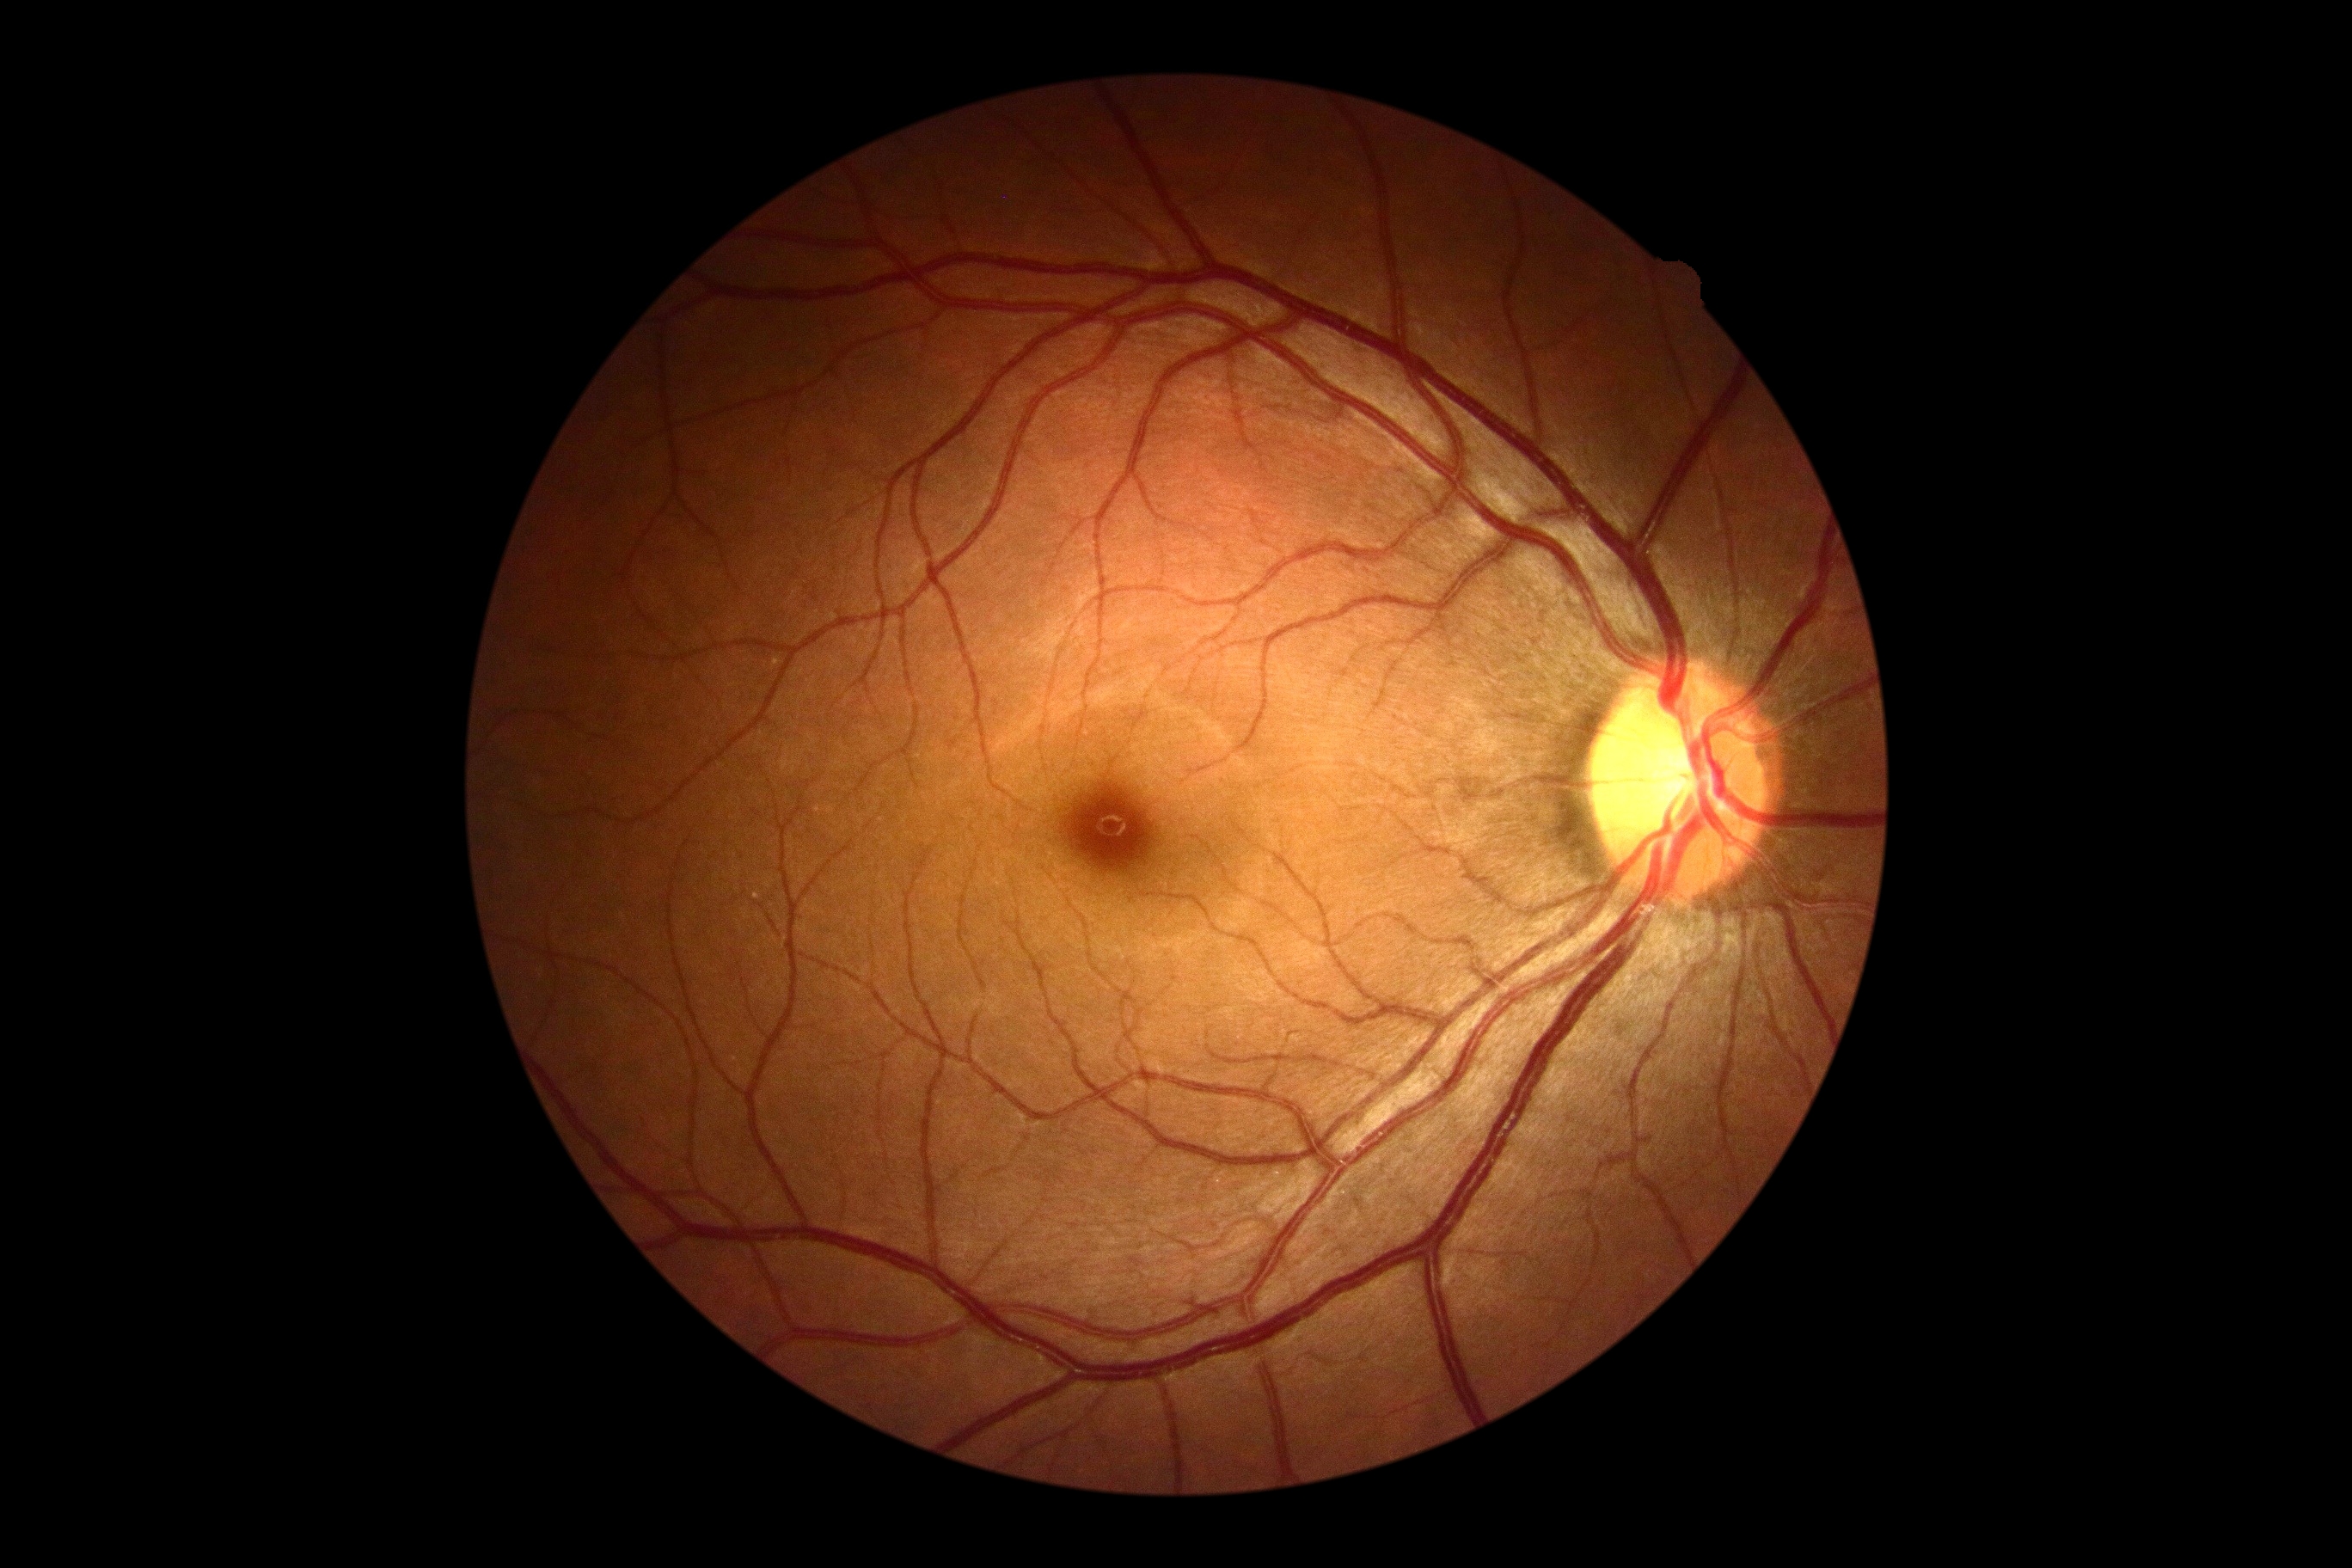 Retinopathy grade: 0 (no apparent retinopathy) — no visible signs of diabetic retinopathy.